Fundus photo: 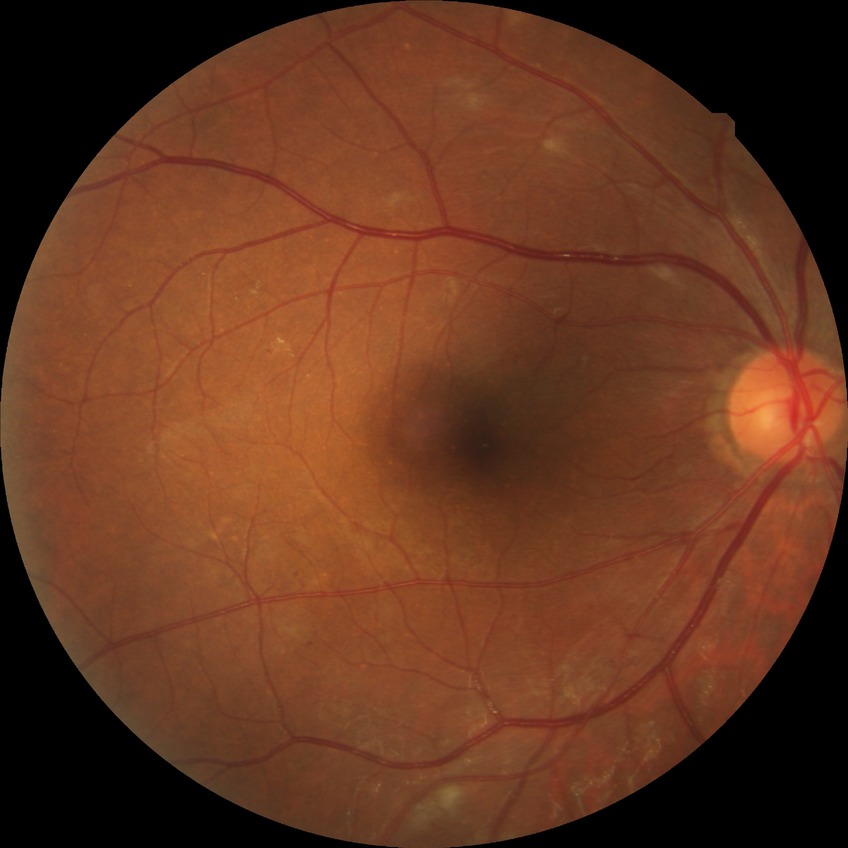

diabetic retinopathy (DR) = simple diabetic retinopathy (SDR).